FOV: 45 degrees.
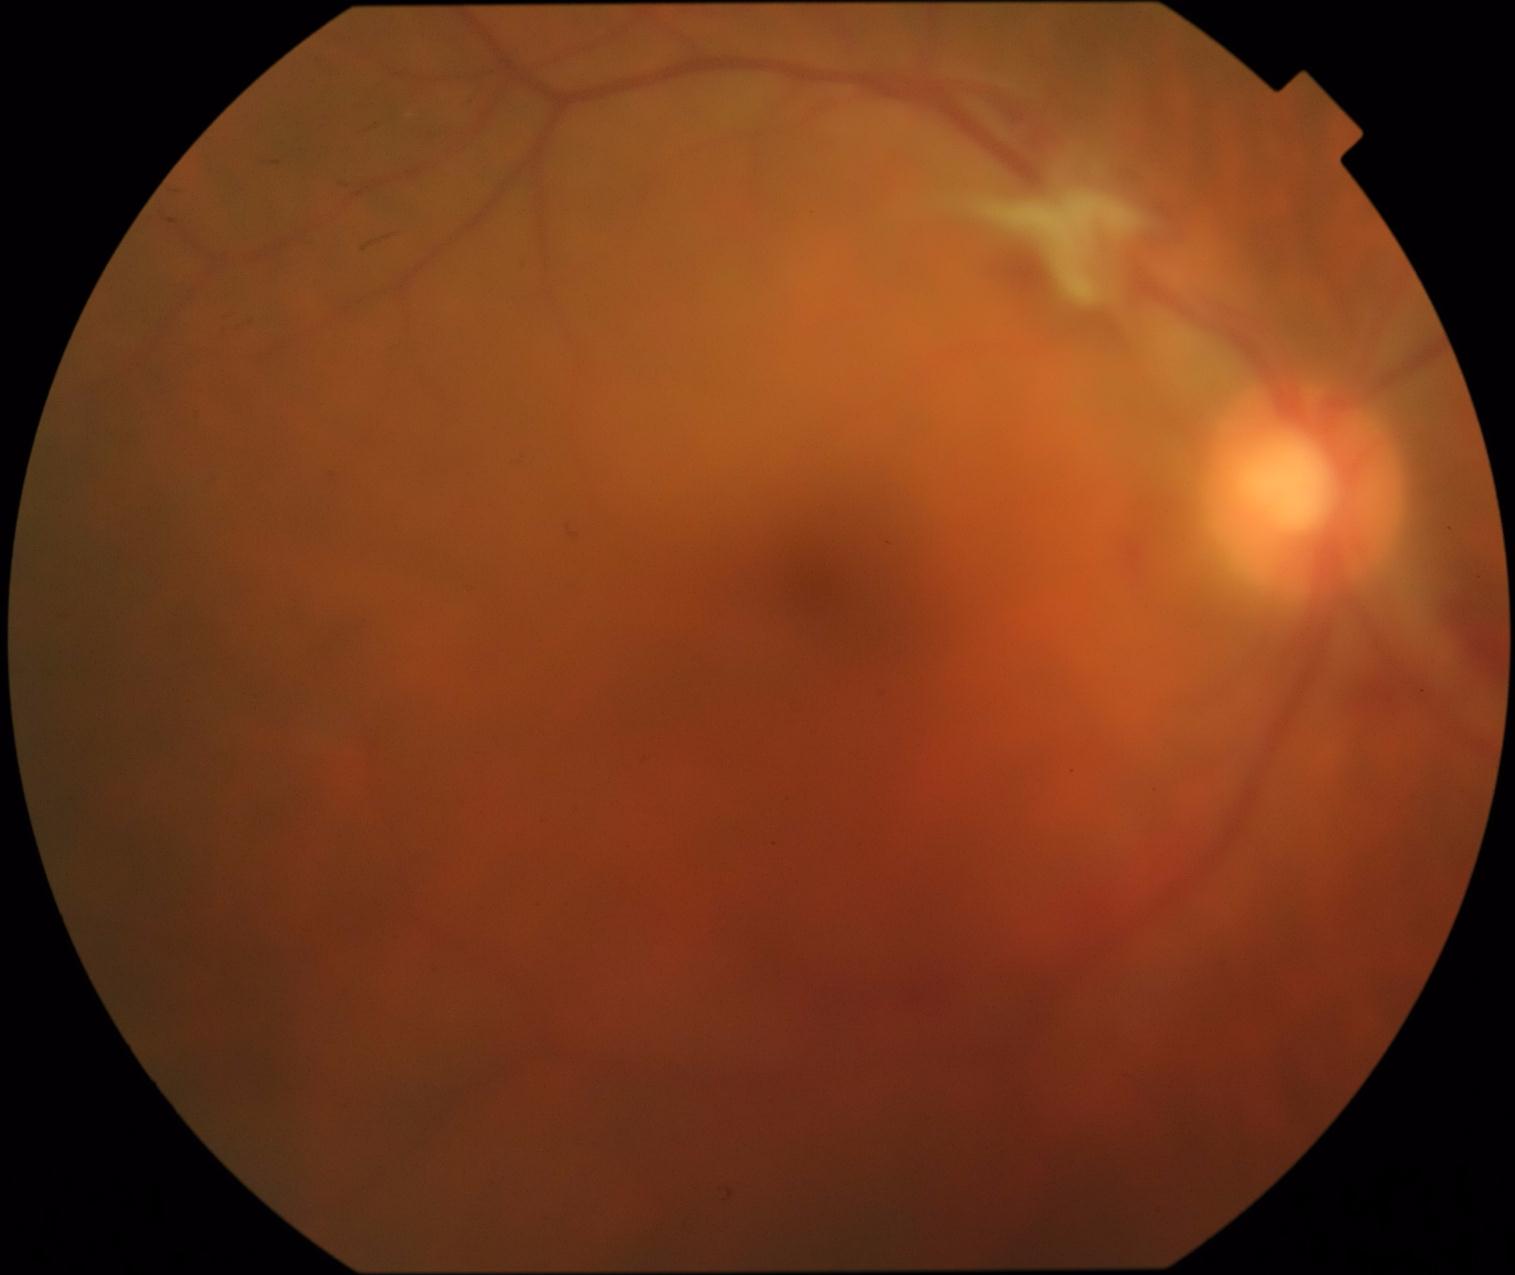
The retinopathy is classified as proliferative diabetic retinopathy. DR severity: grade 4 (PDR).